Camera: Remidio smartphone fundus camera:
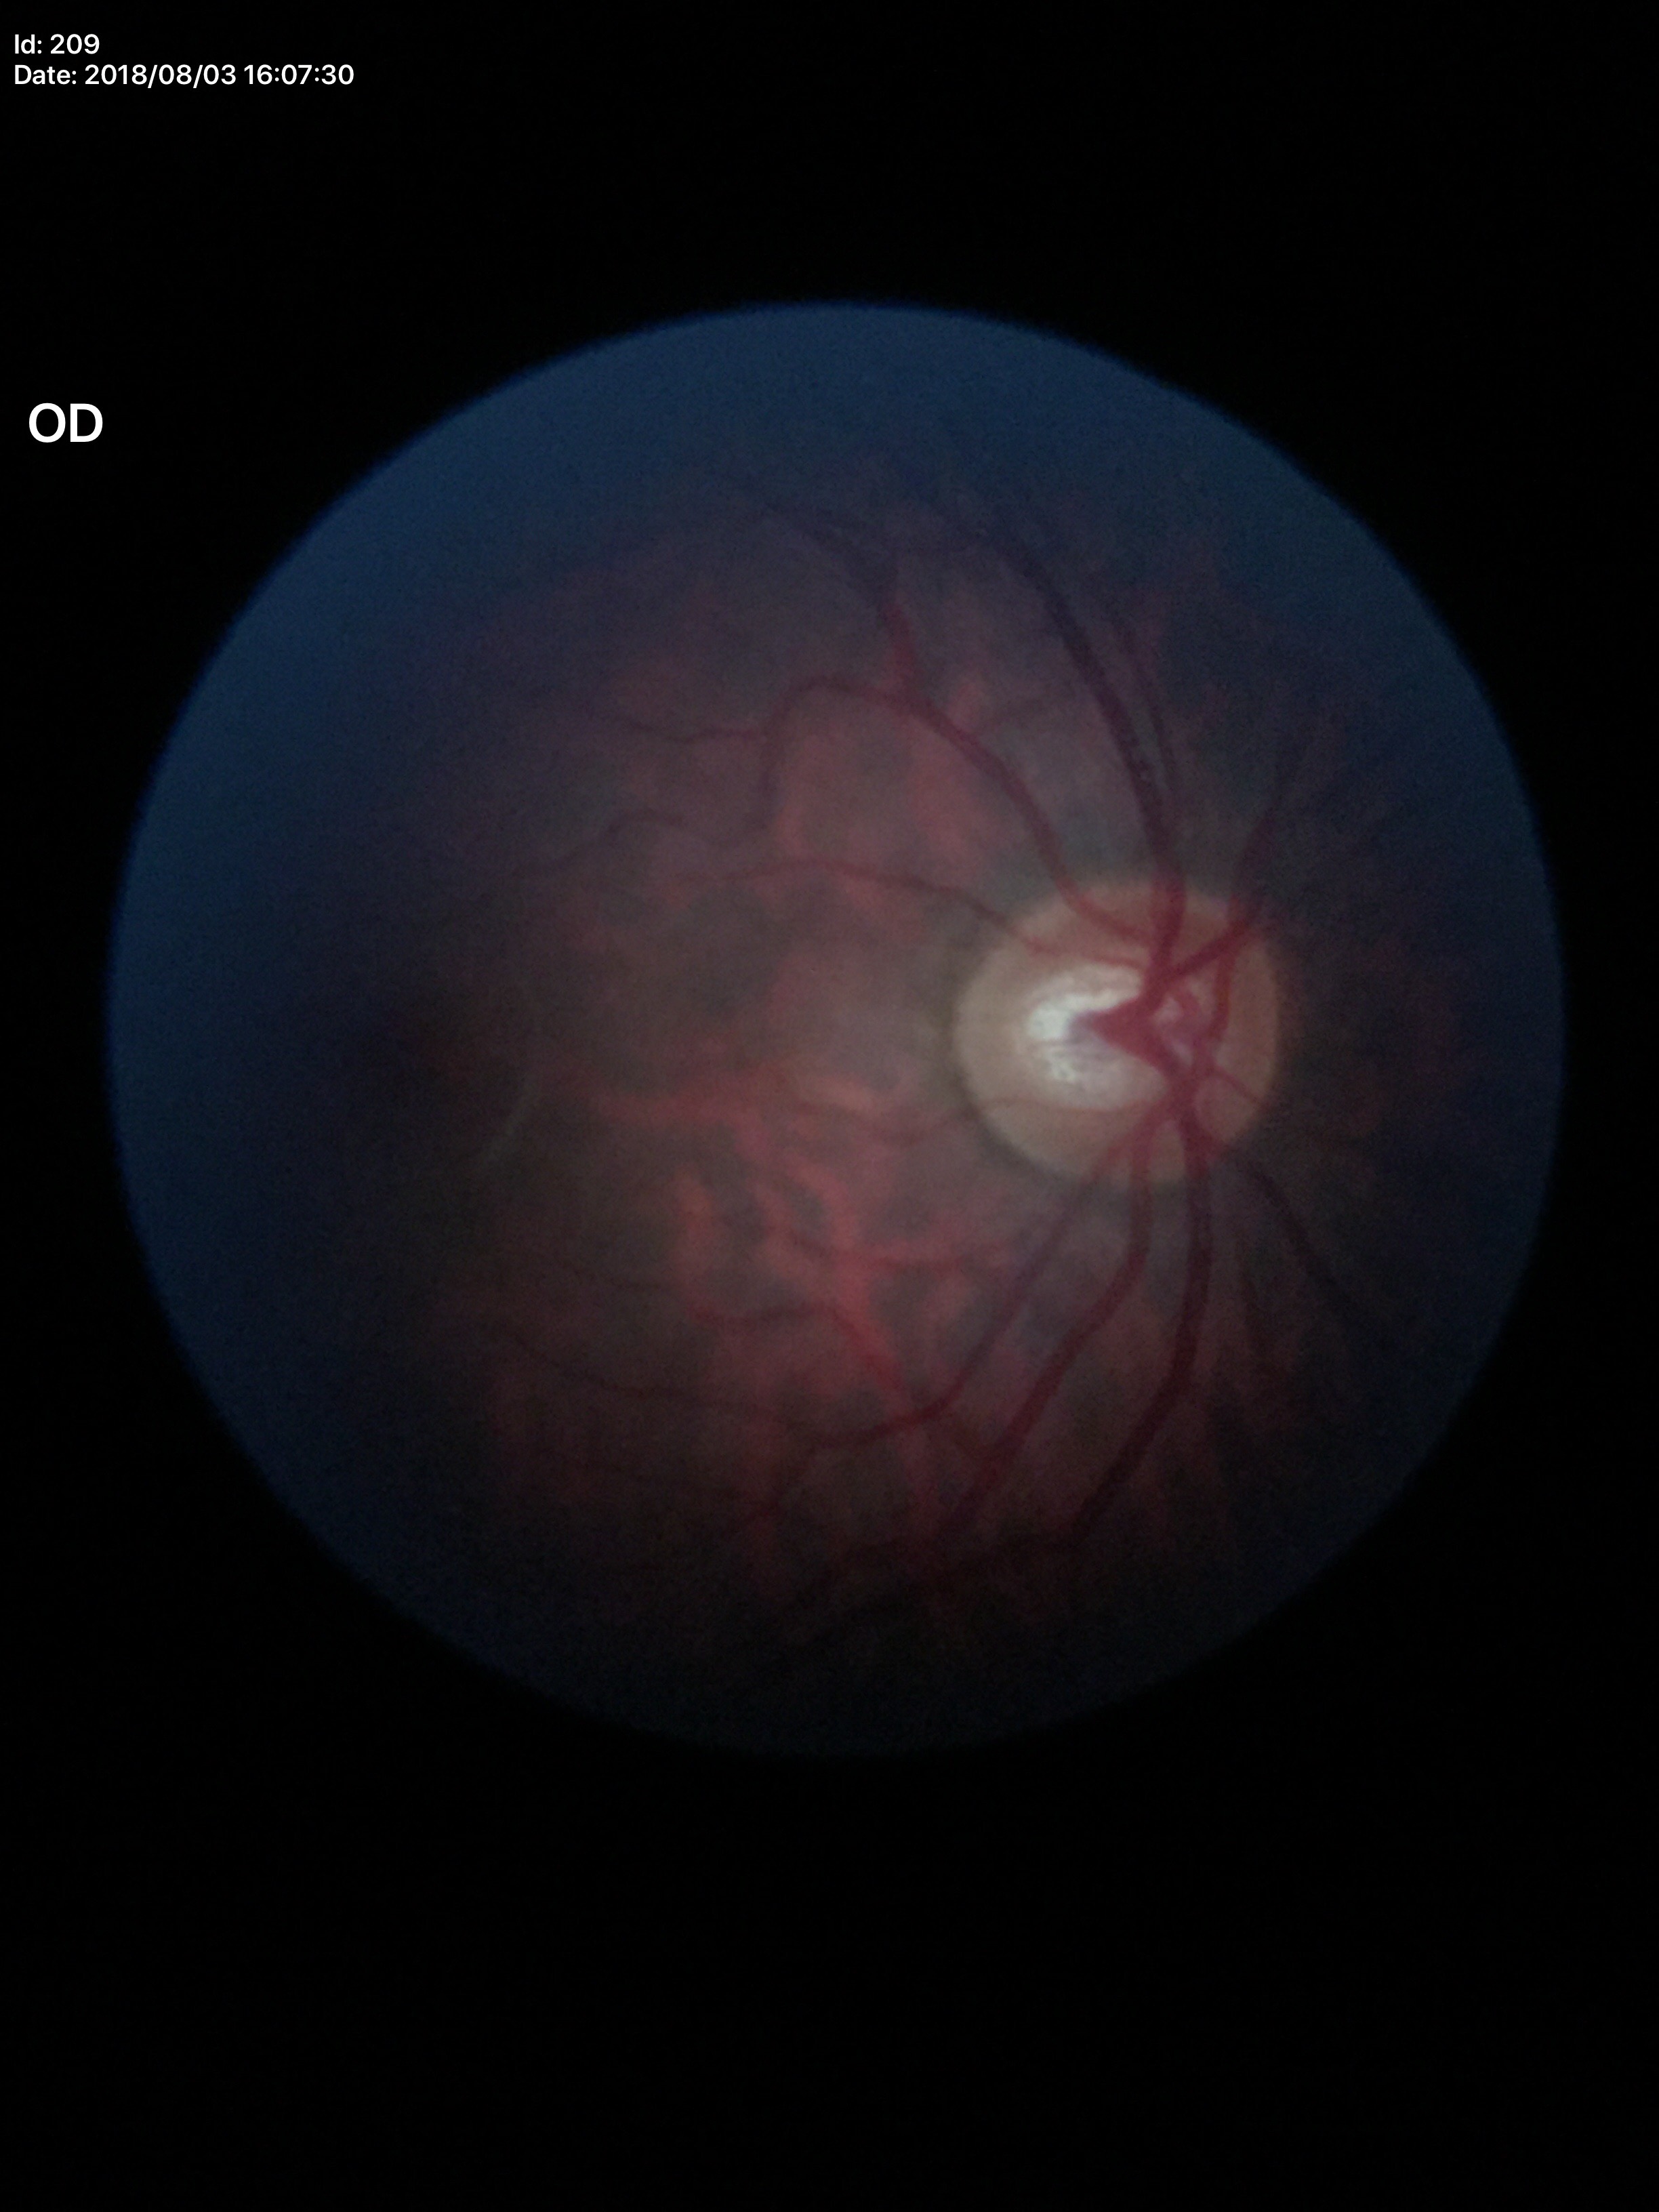

Optic disc analysis:
• vertical C/D ratio (VCDR): 0.59
• horizontal cup-to-disc ratio (HCDR): 0.67
• Glaucoma screening impression: suspect